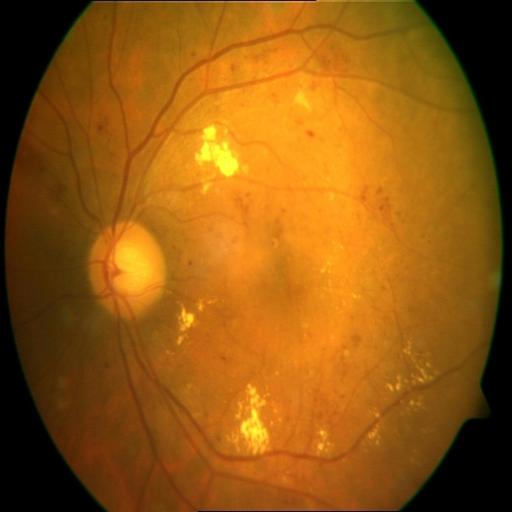
Diagnosis (3):
- exudation
- hemorrhagic retinopathy
- tessellation